848x848 · graded on the modified Davis scale — 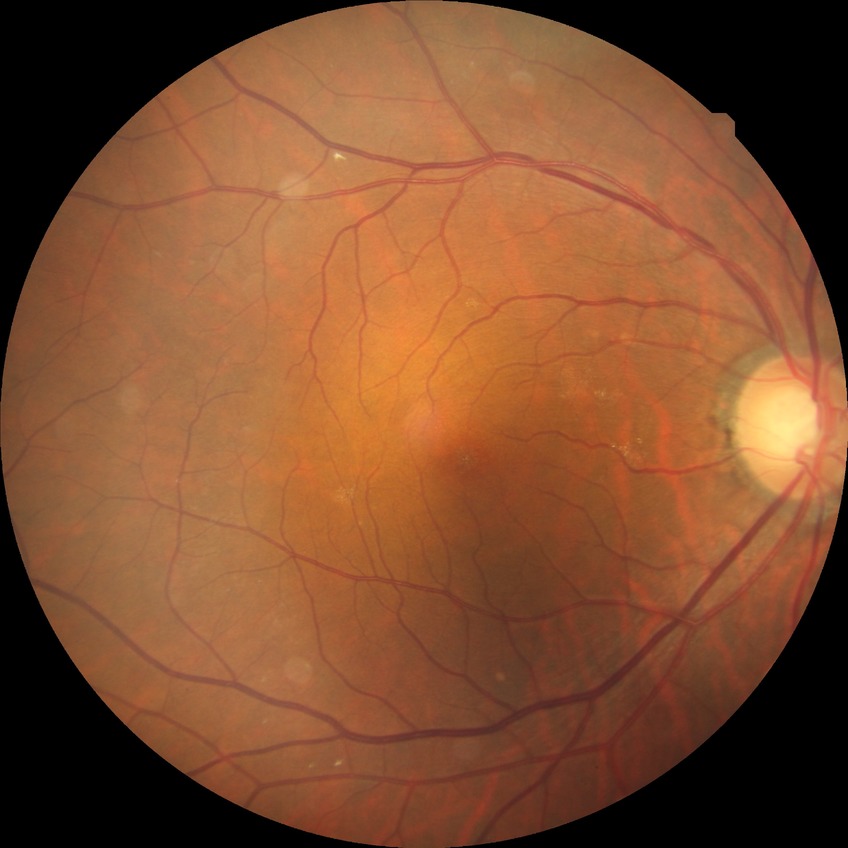
diabetic retinopathy grade=no diabetic retinopathy.